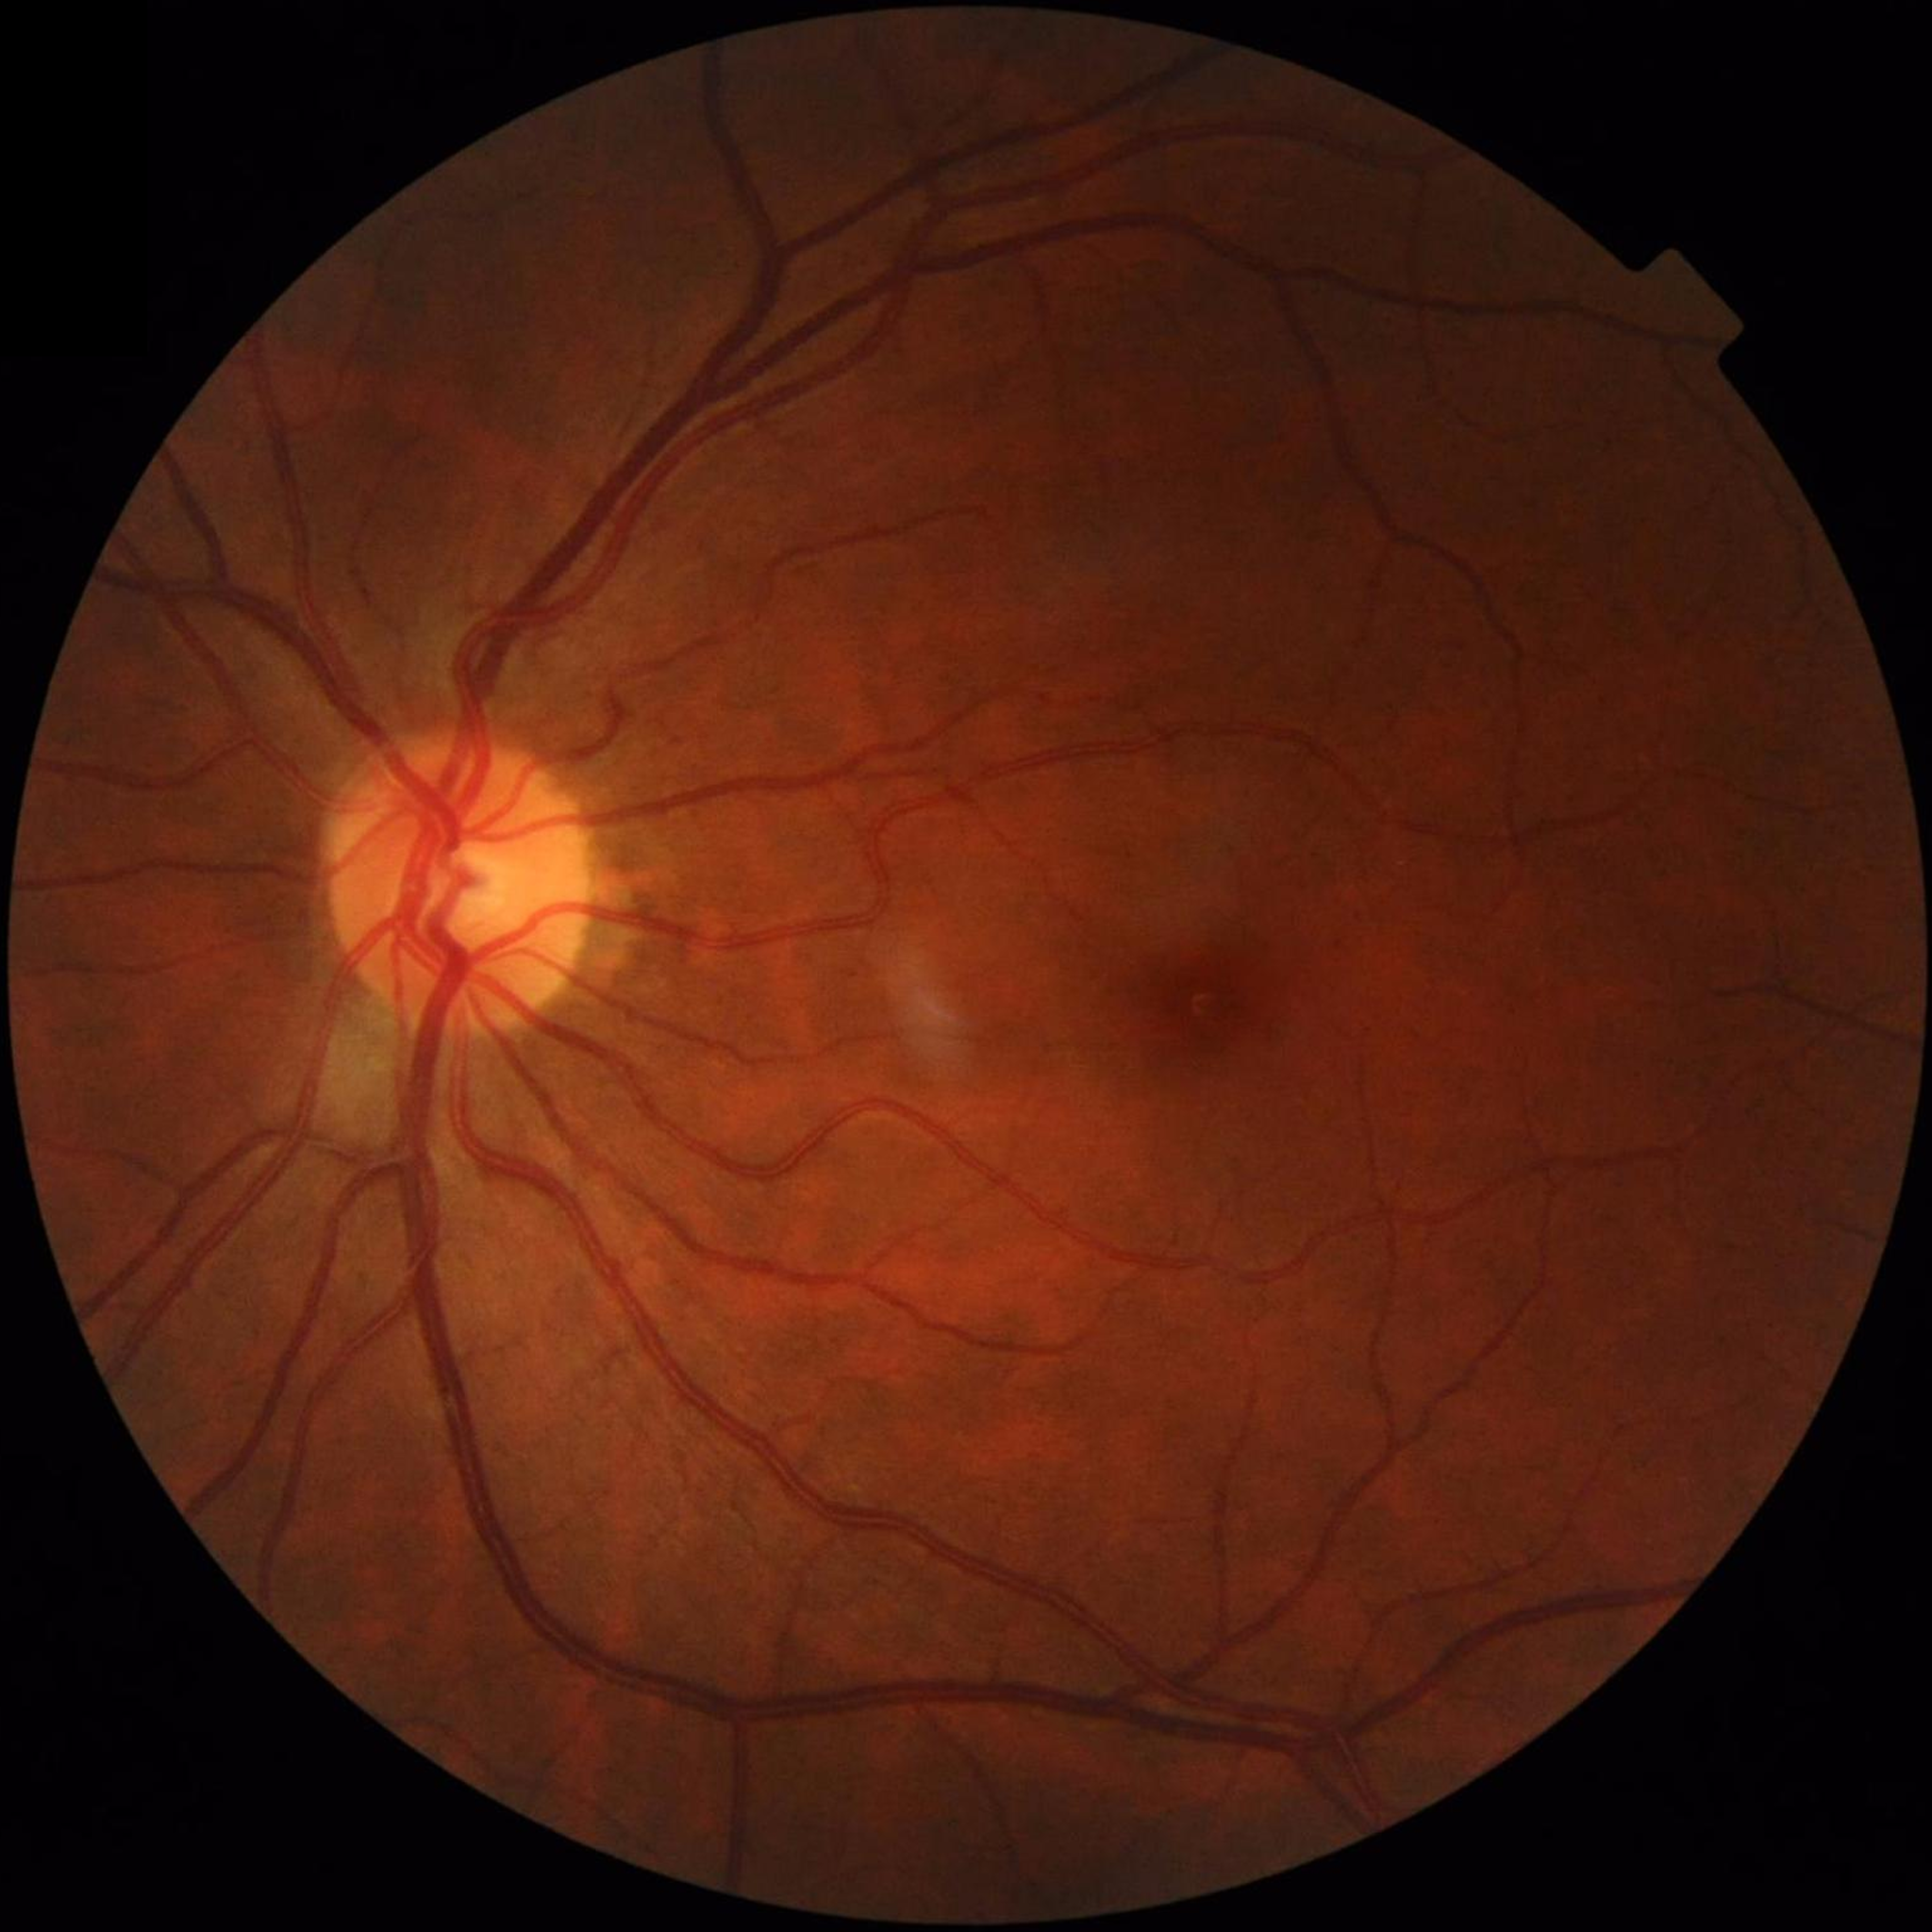

From a control without AMD, diabetic retinopathy, or glaucoma.